Acquired on the Phoenix ICON; Phoenix ICON wide-field infant fundus image:
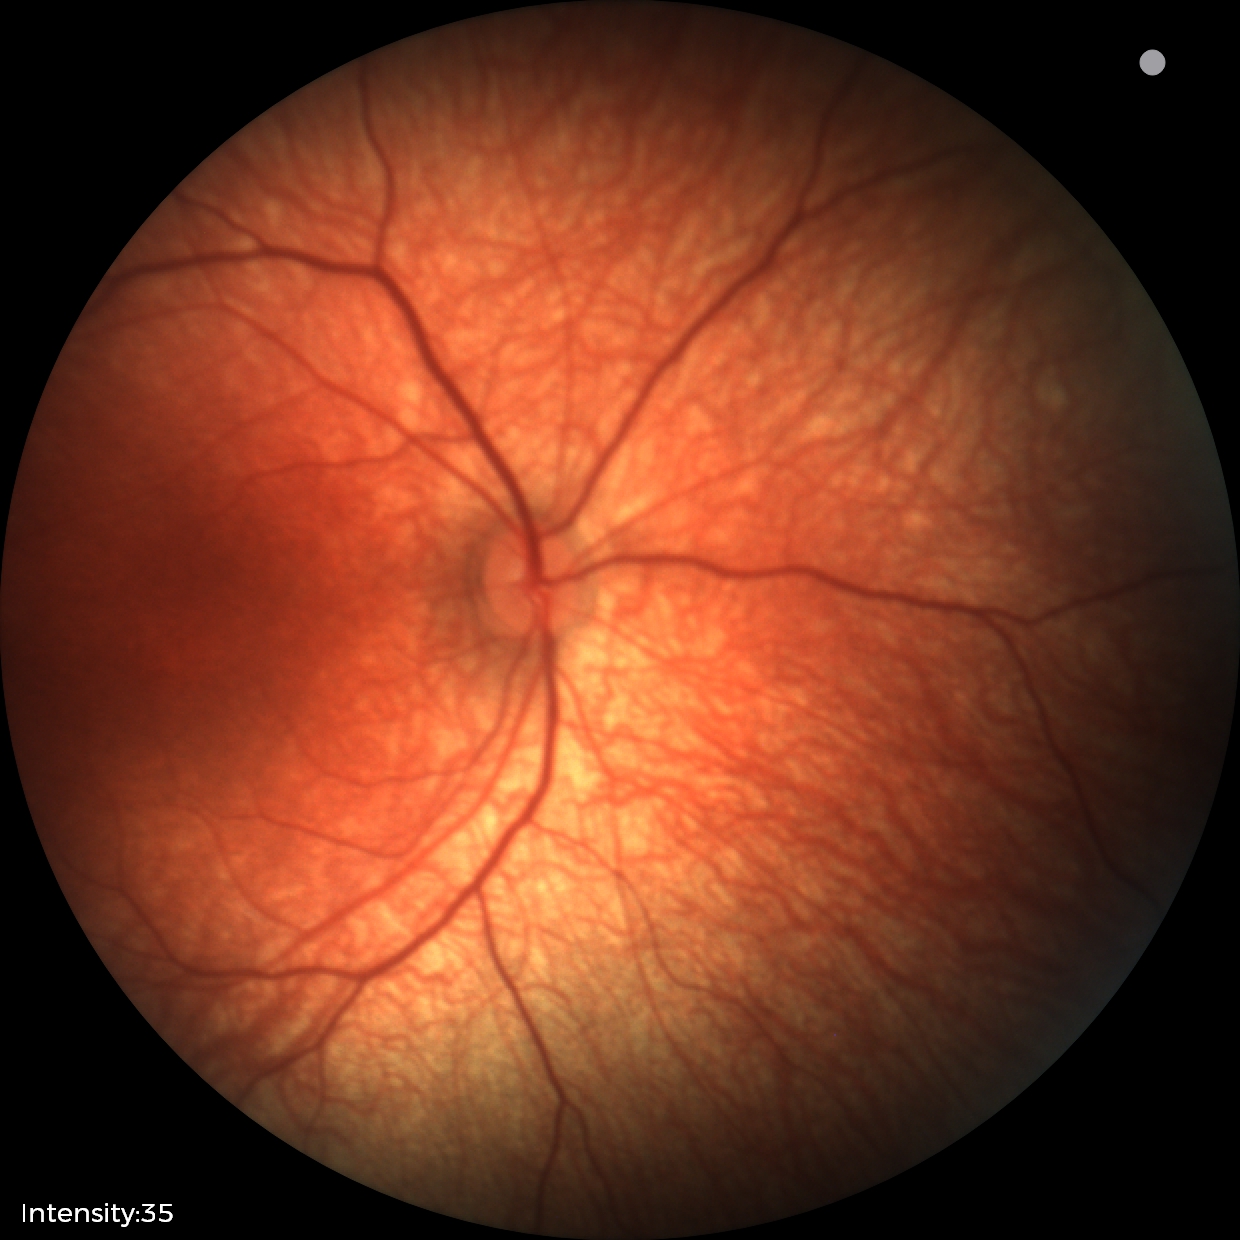

Normal screening examination.